Retinal fundus photograph
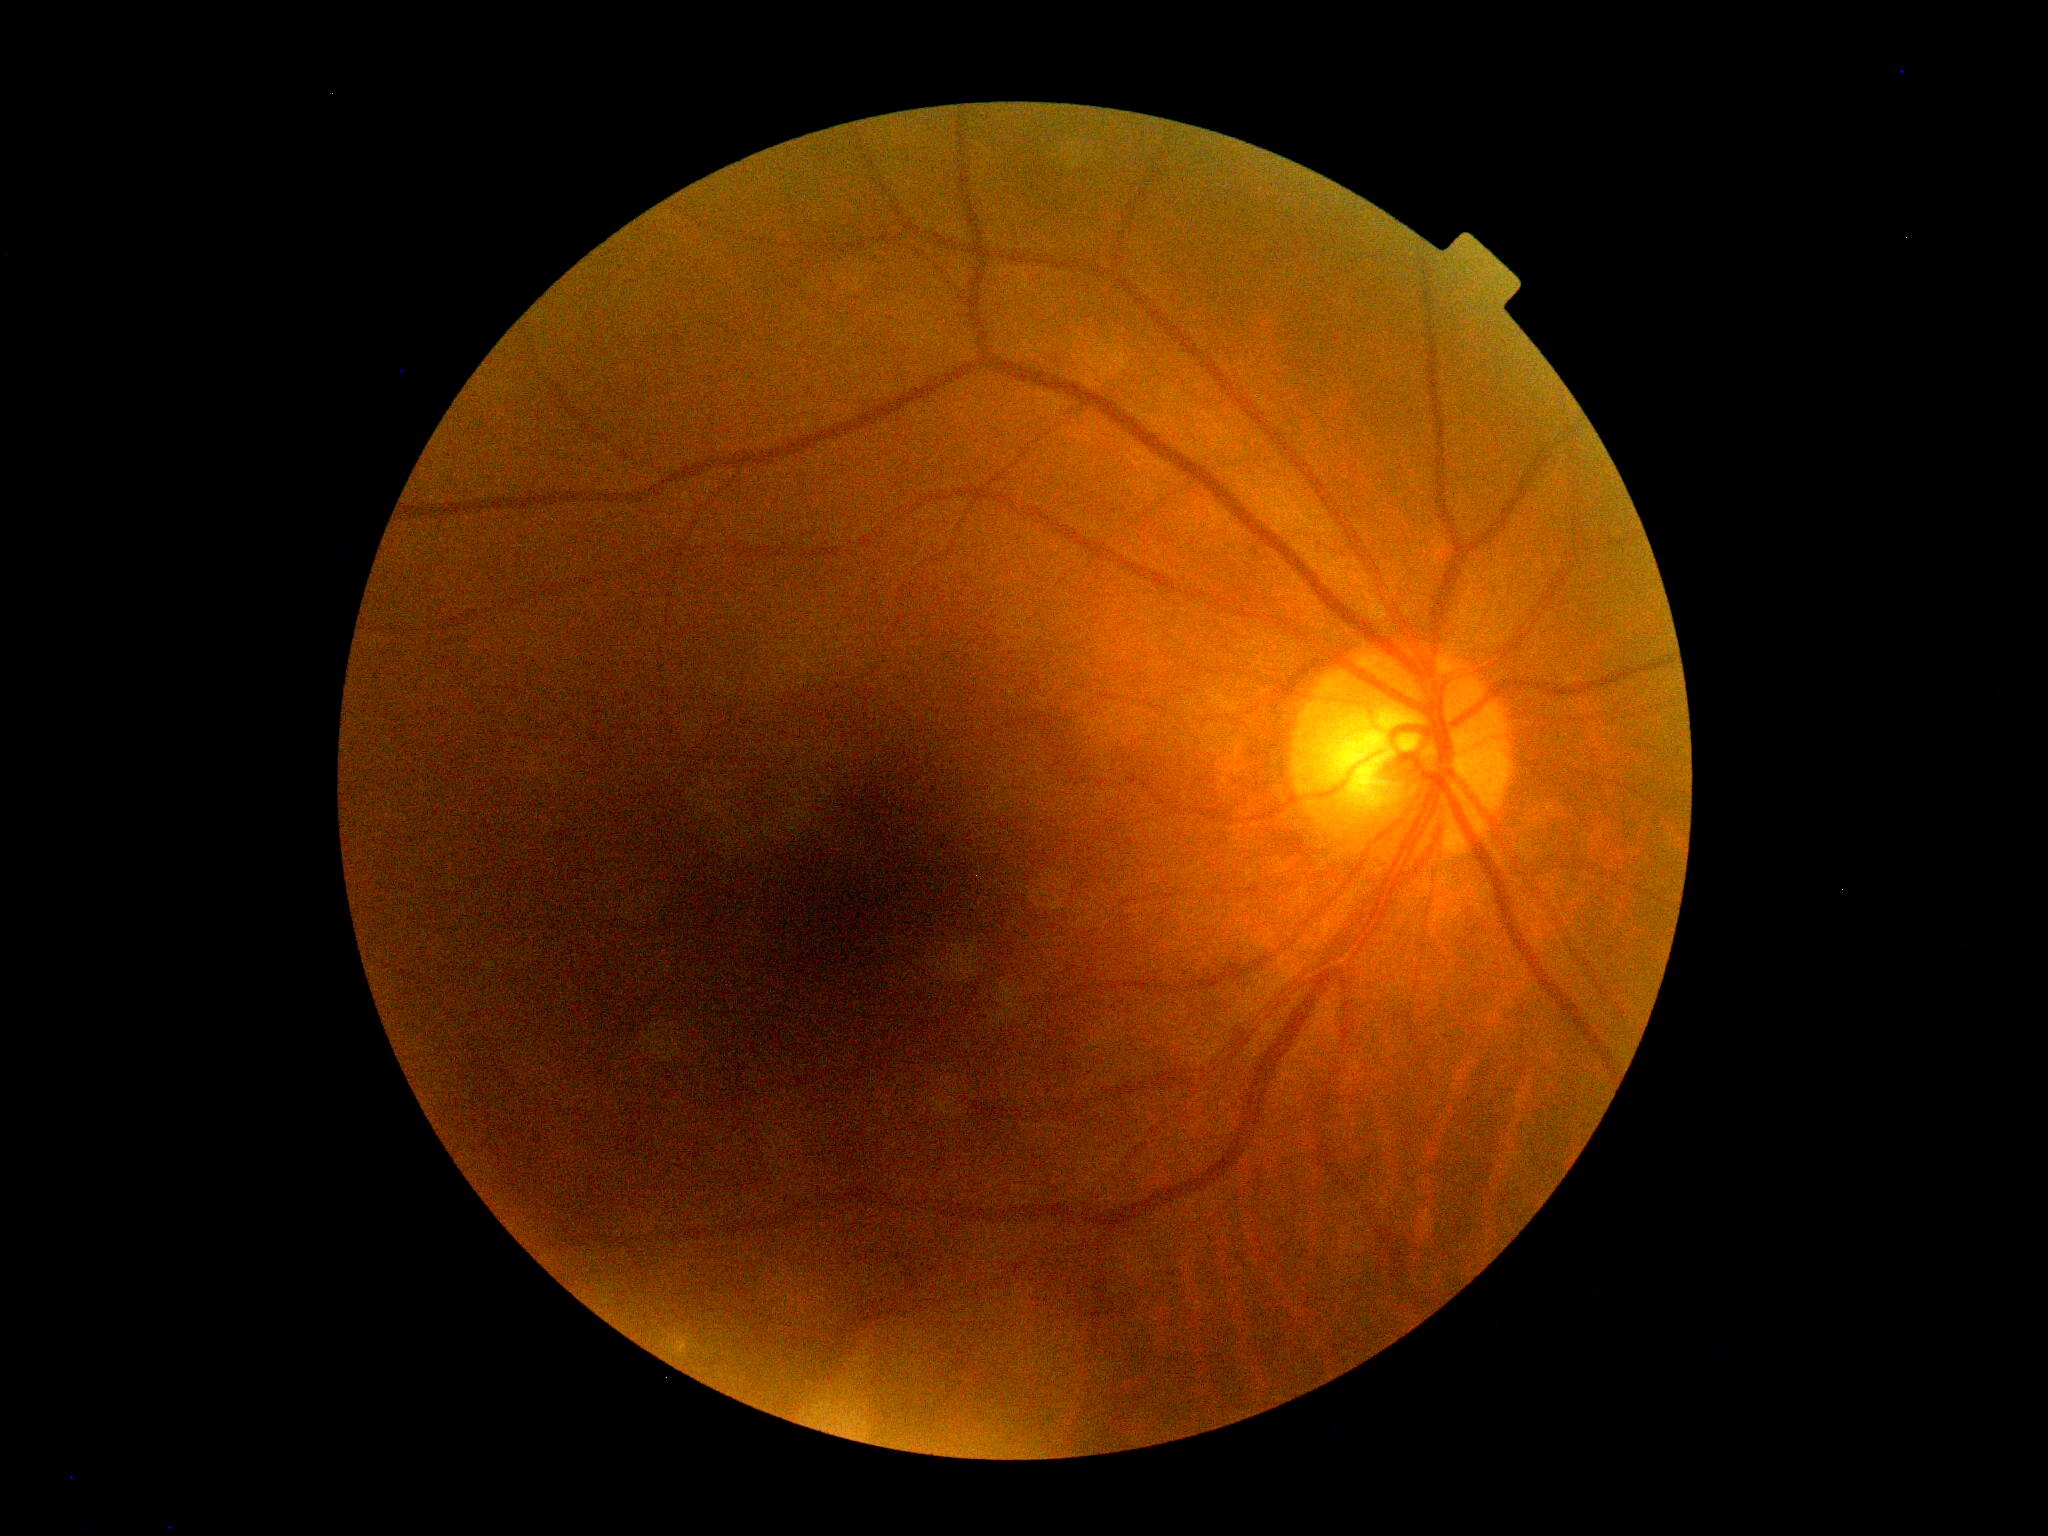
Retinopathy grade is 0/4.